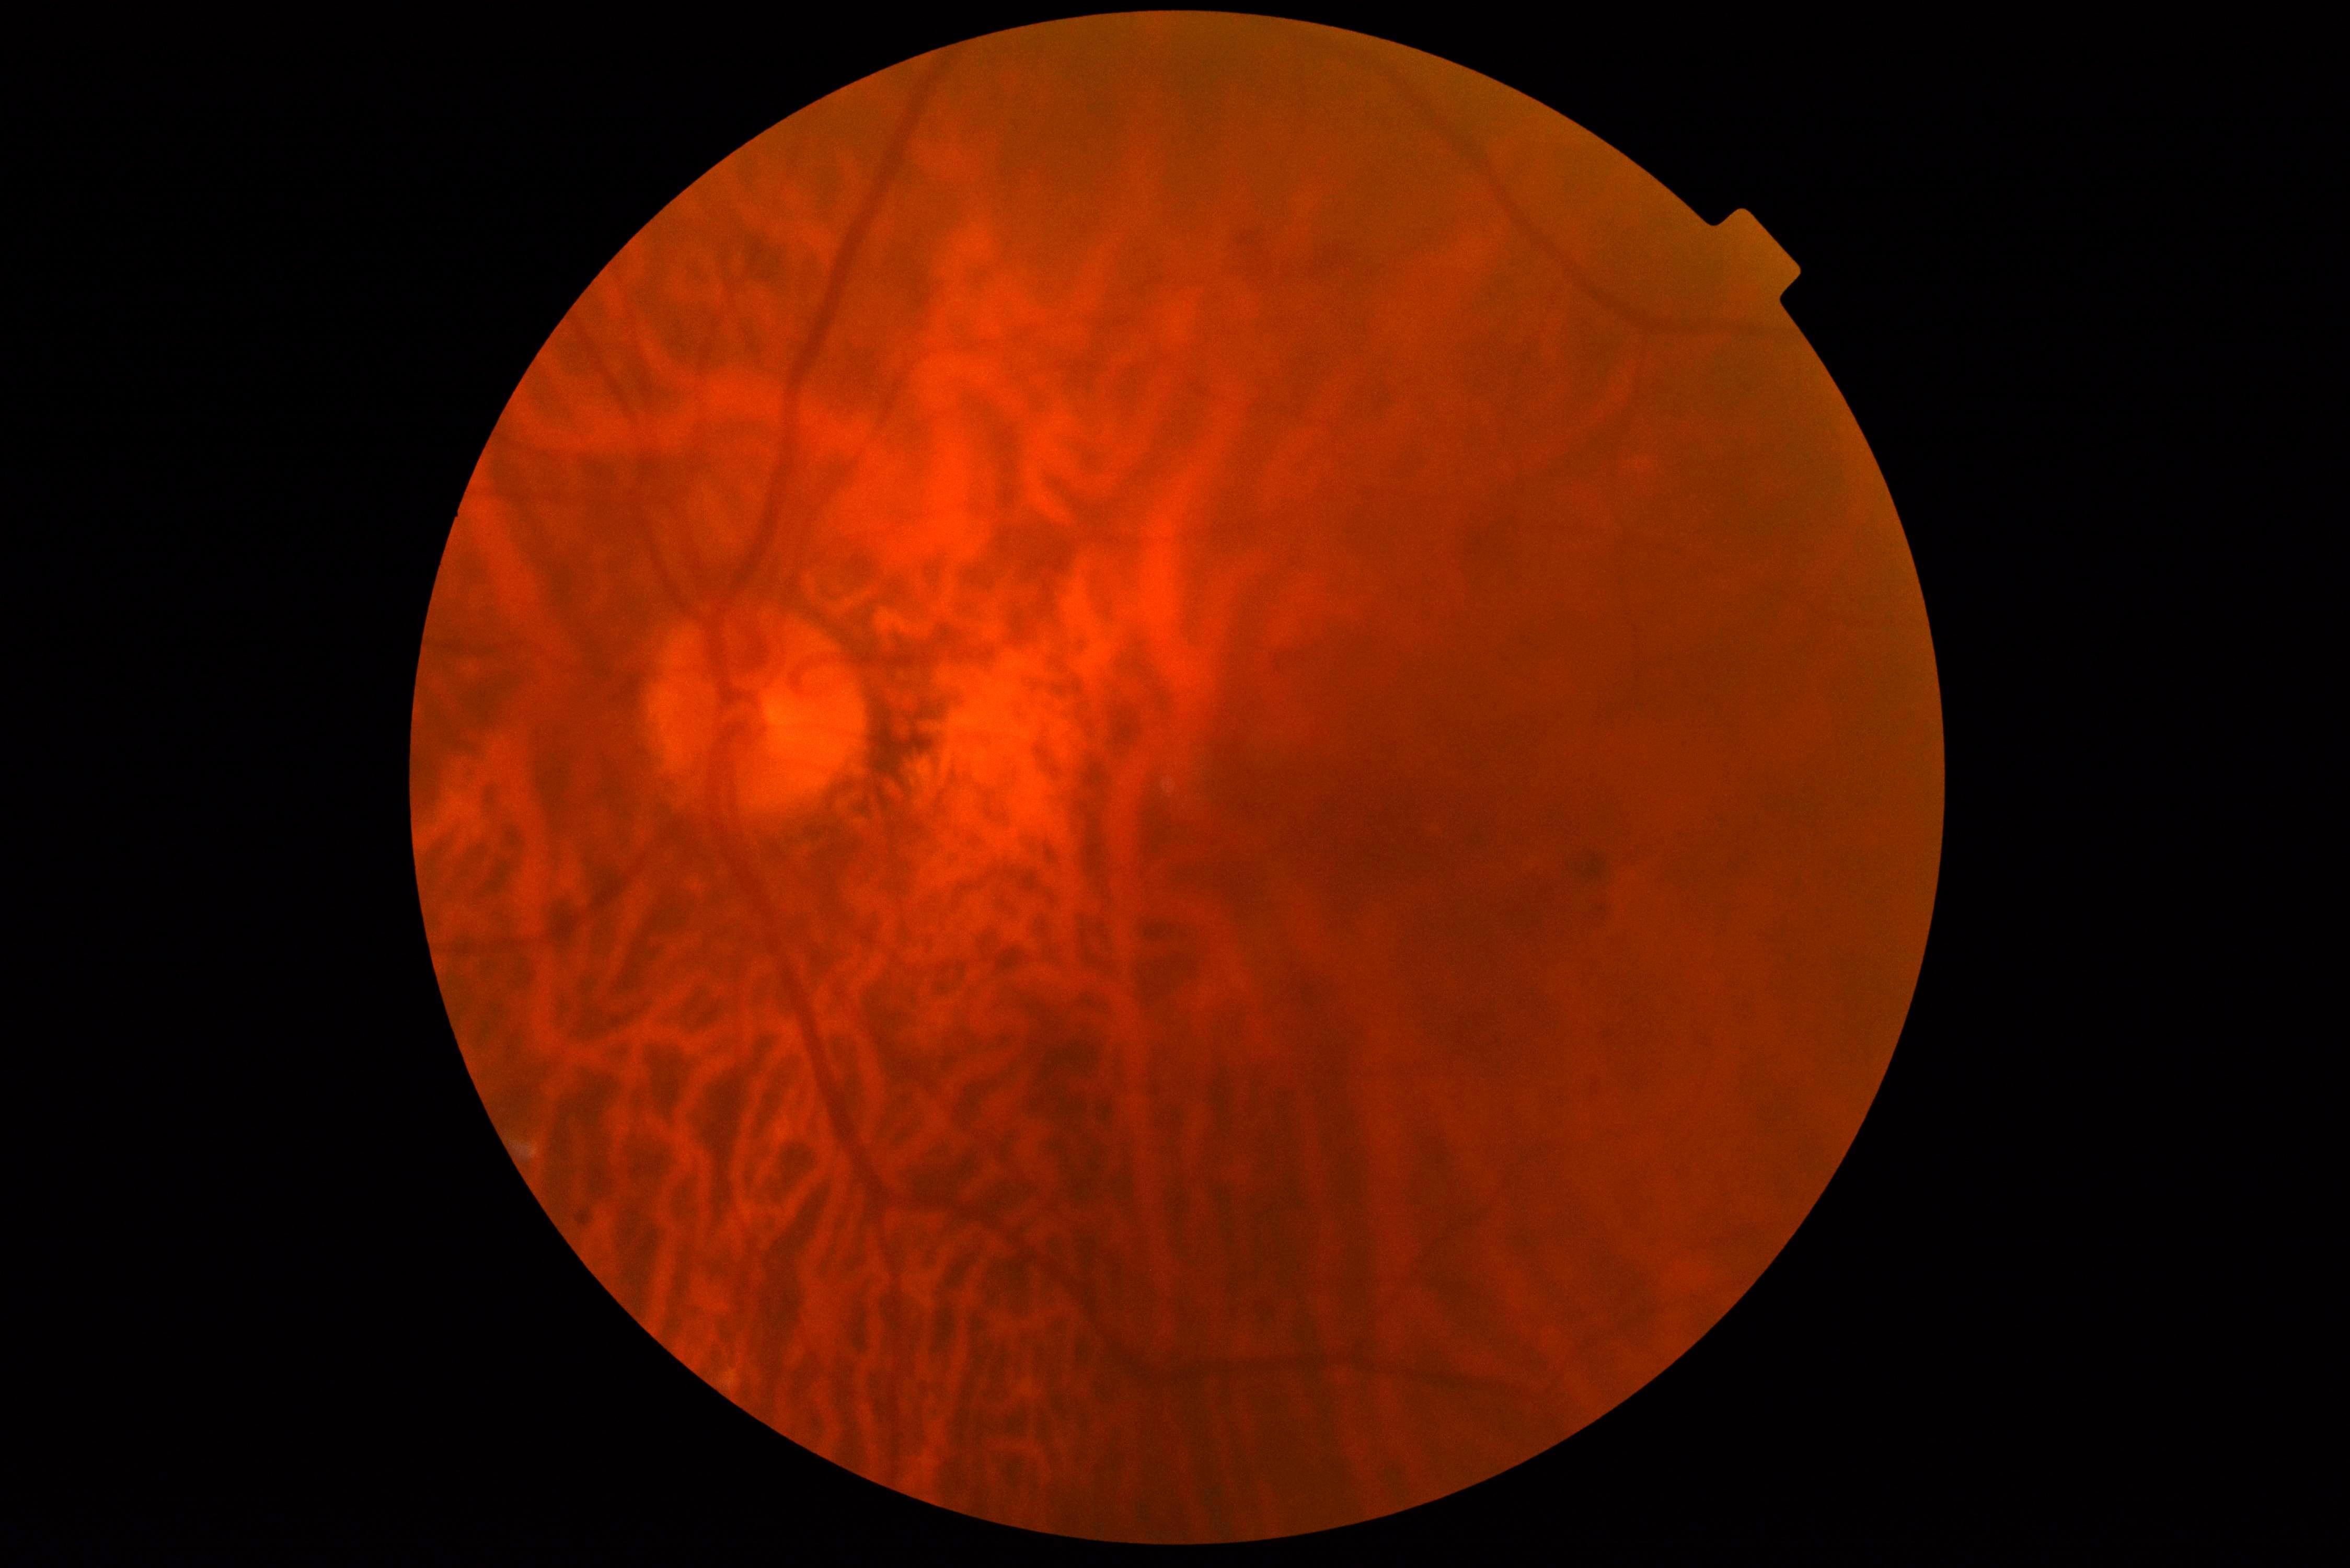
Annotations:
• DR class — non-proliferative diabetic retinopathy
• DR stage — grade 2 — more than just microaneurysms but less than severe NPDR